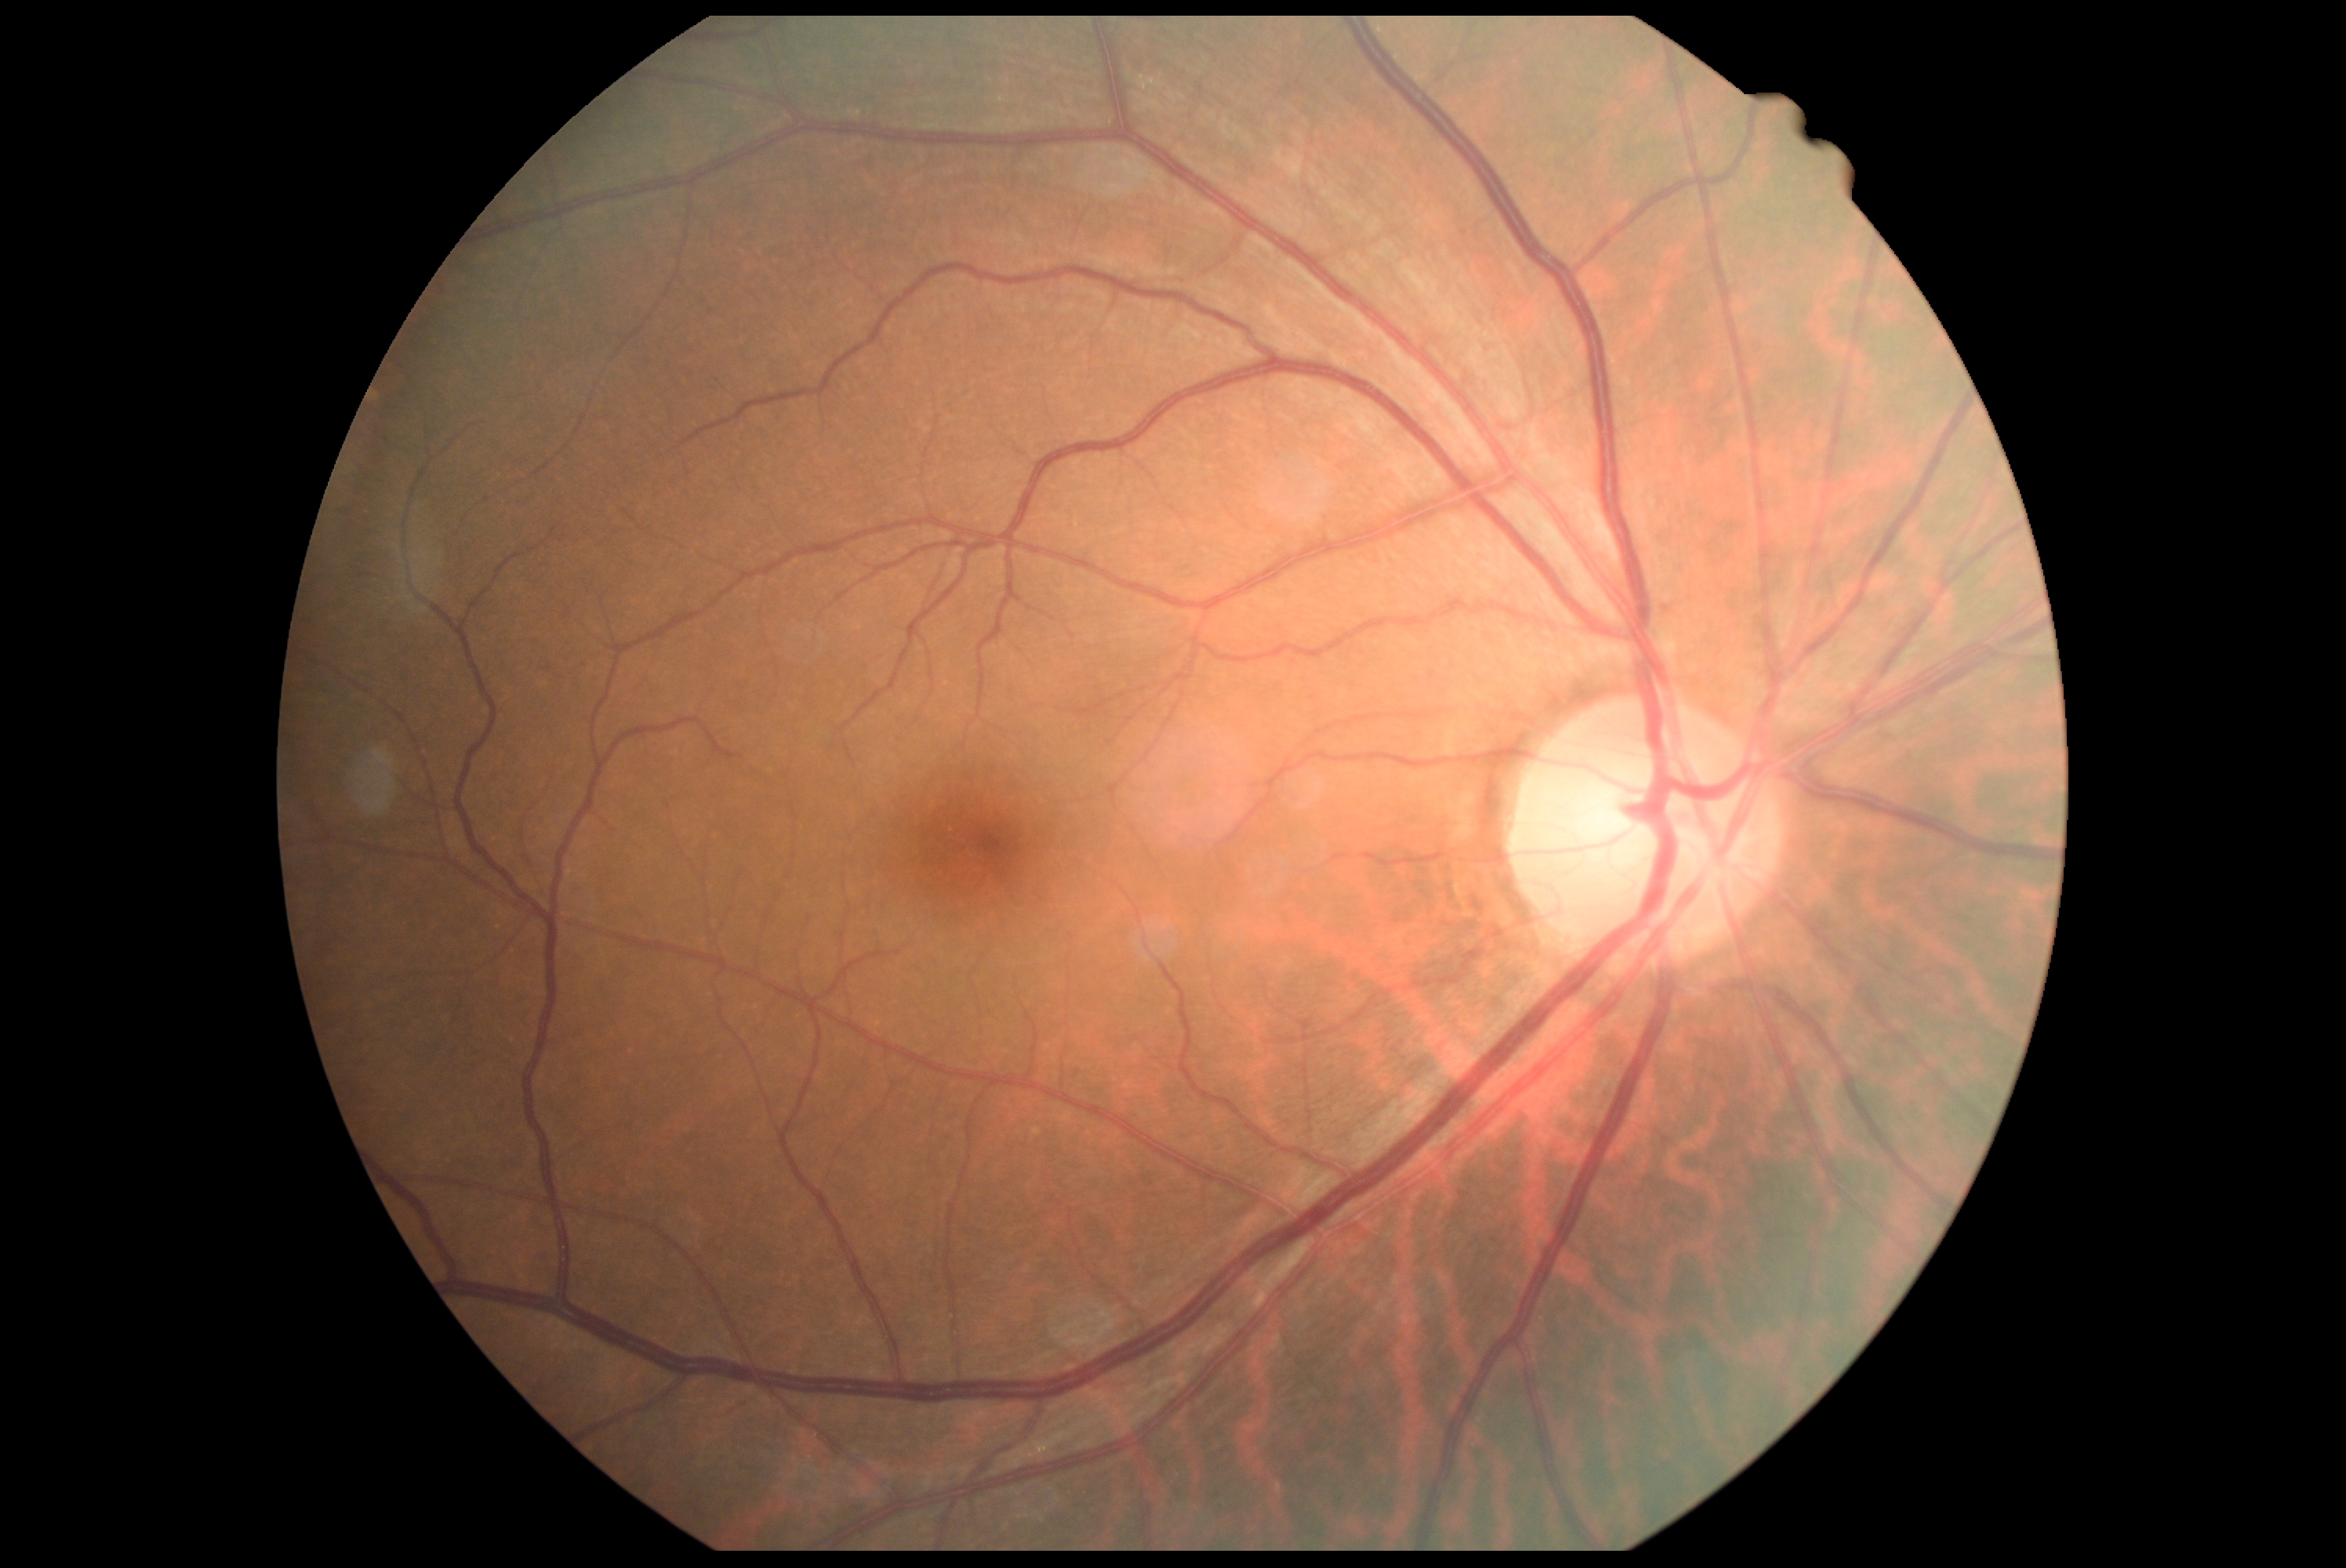 DR severity is grade 0 (no apparent retinopathy).